Diabetic retinopathy graded by the modified Davis classification:
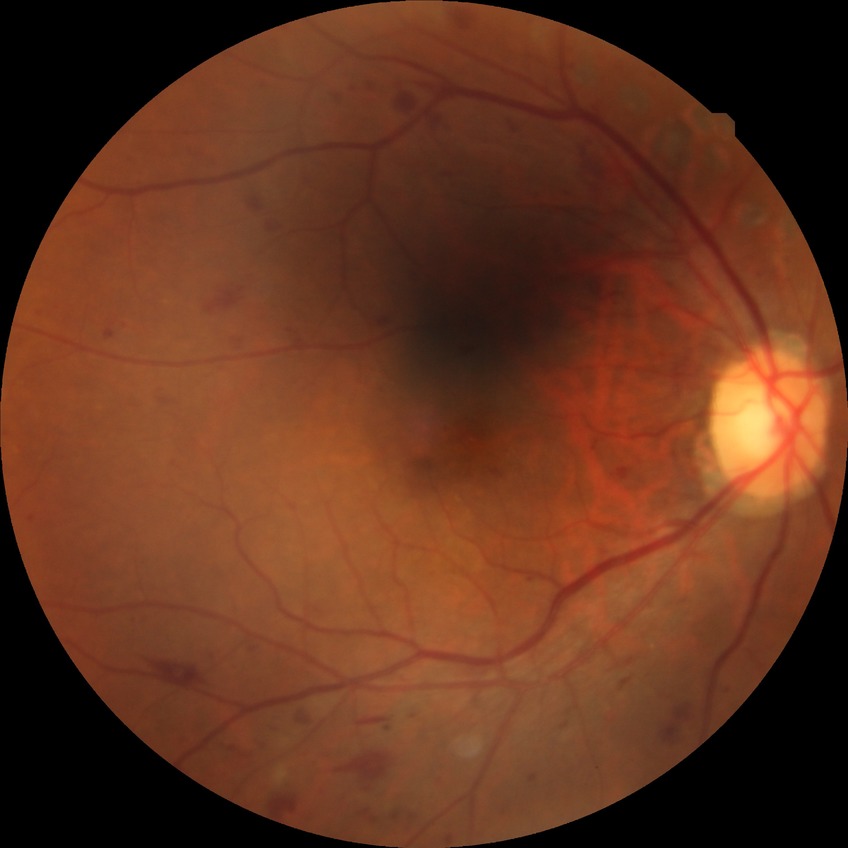 diabetic retinopathy (DR): proliferative diabetic retinopathy (PDR).